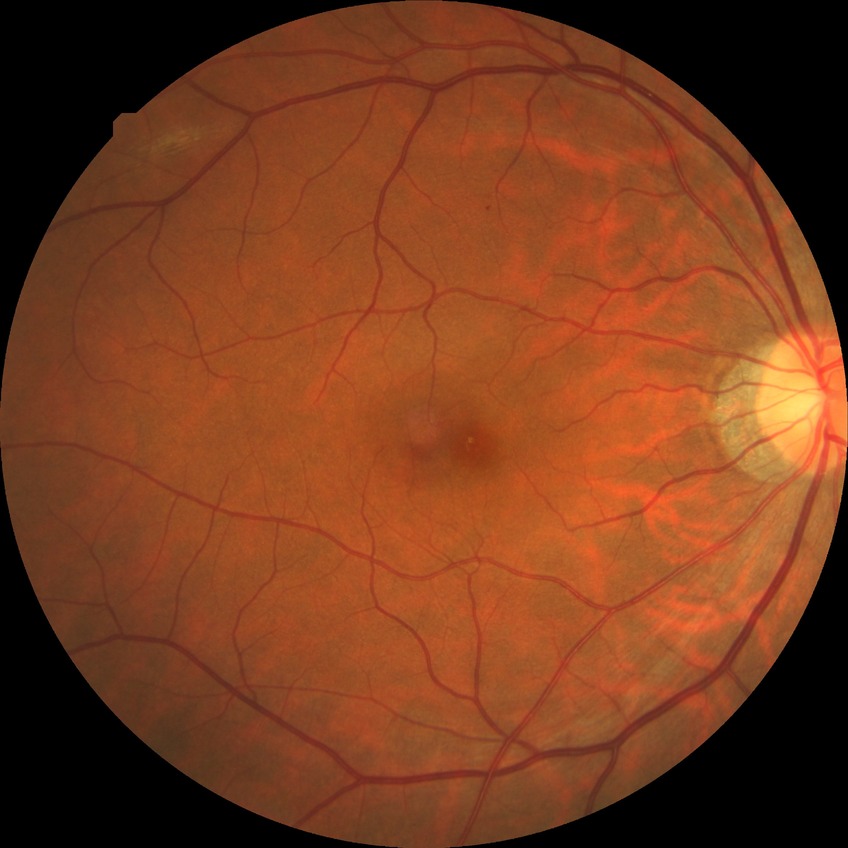

Diabetic retinopathy (DR) is no diabetic retinopathy (NDR).